848x848 · NIDEK AFC-230:
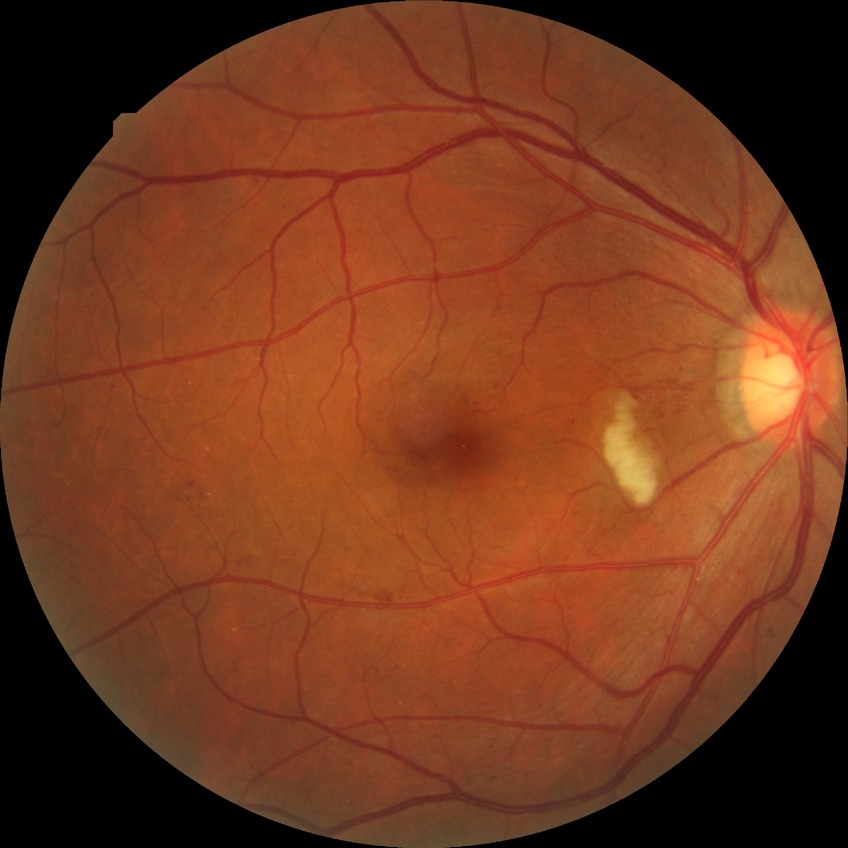 DR class: non-proliferative diabetic retinopathy | retinopathy grade: pre-proliferative diabetic retinopathy.